Fundus photo; 2352x1568 — 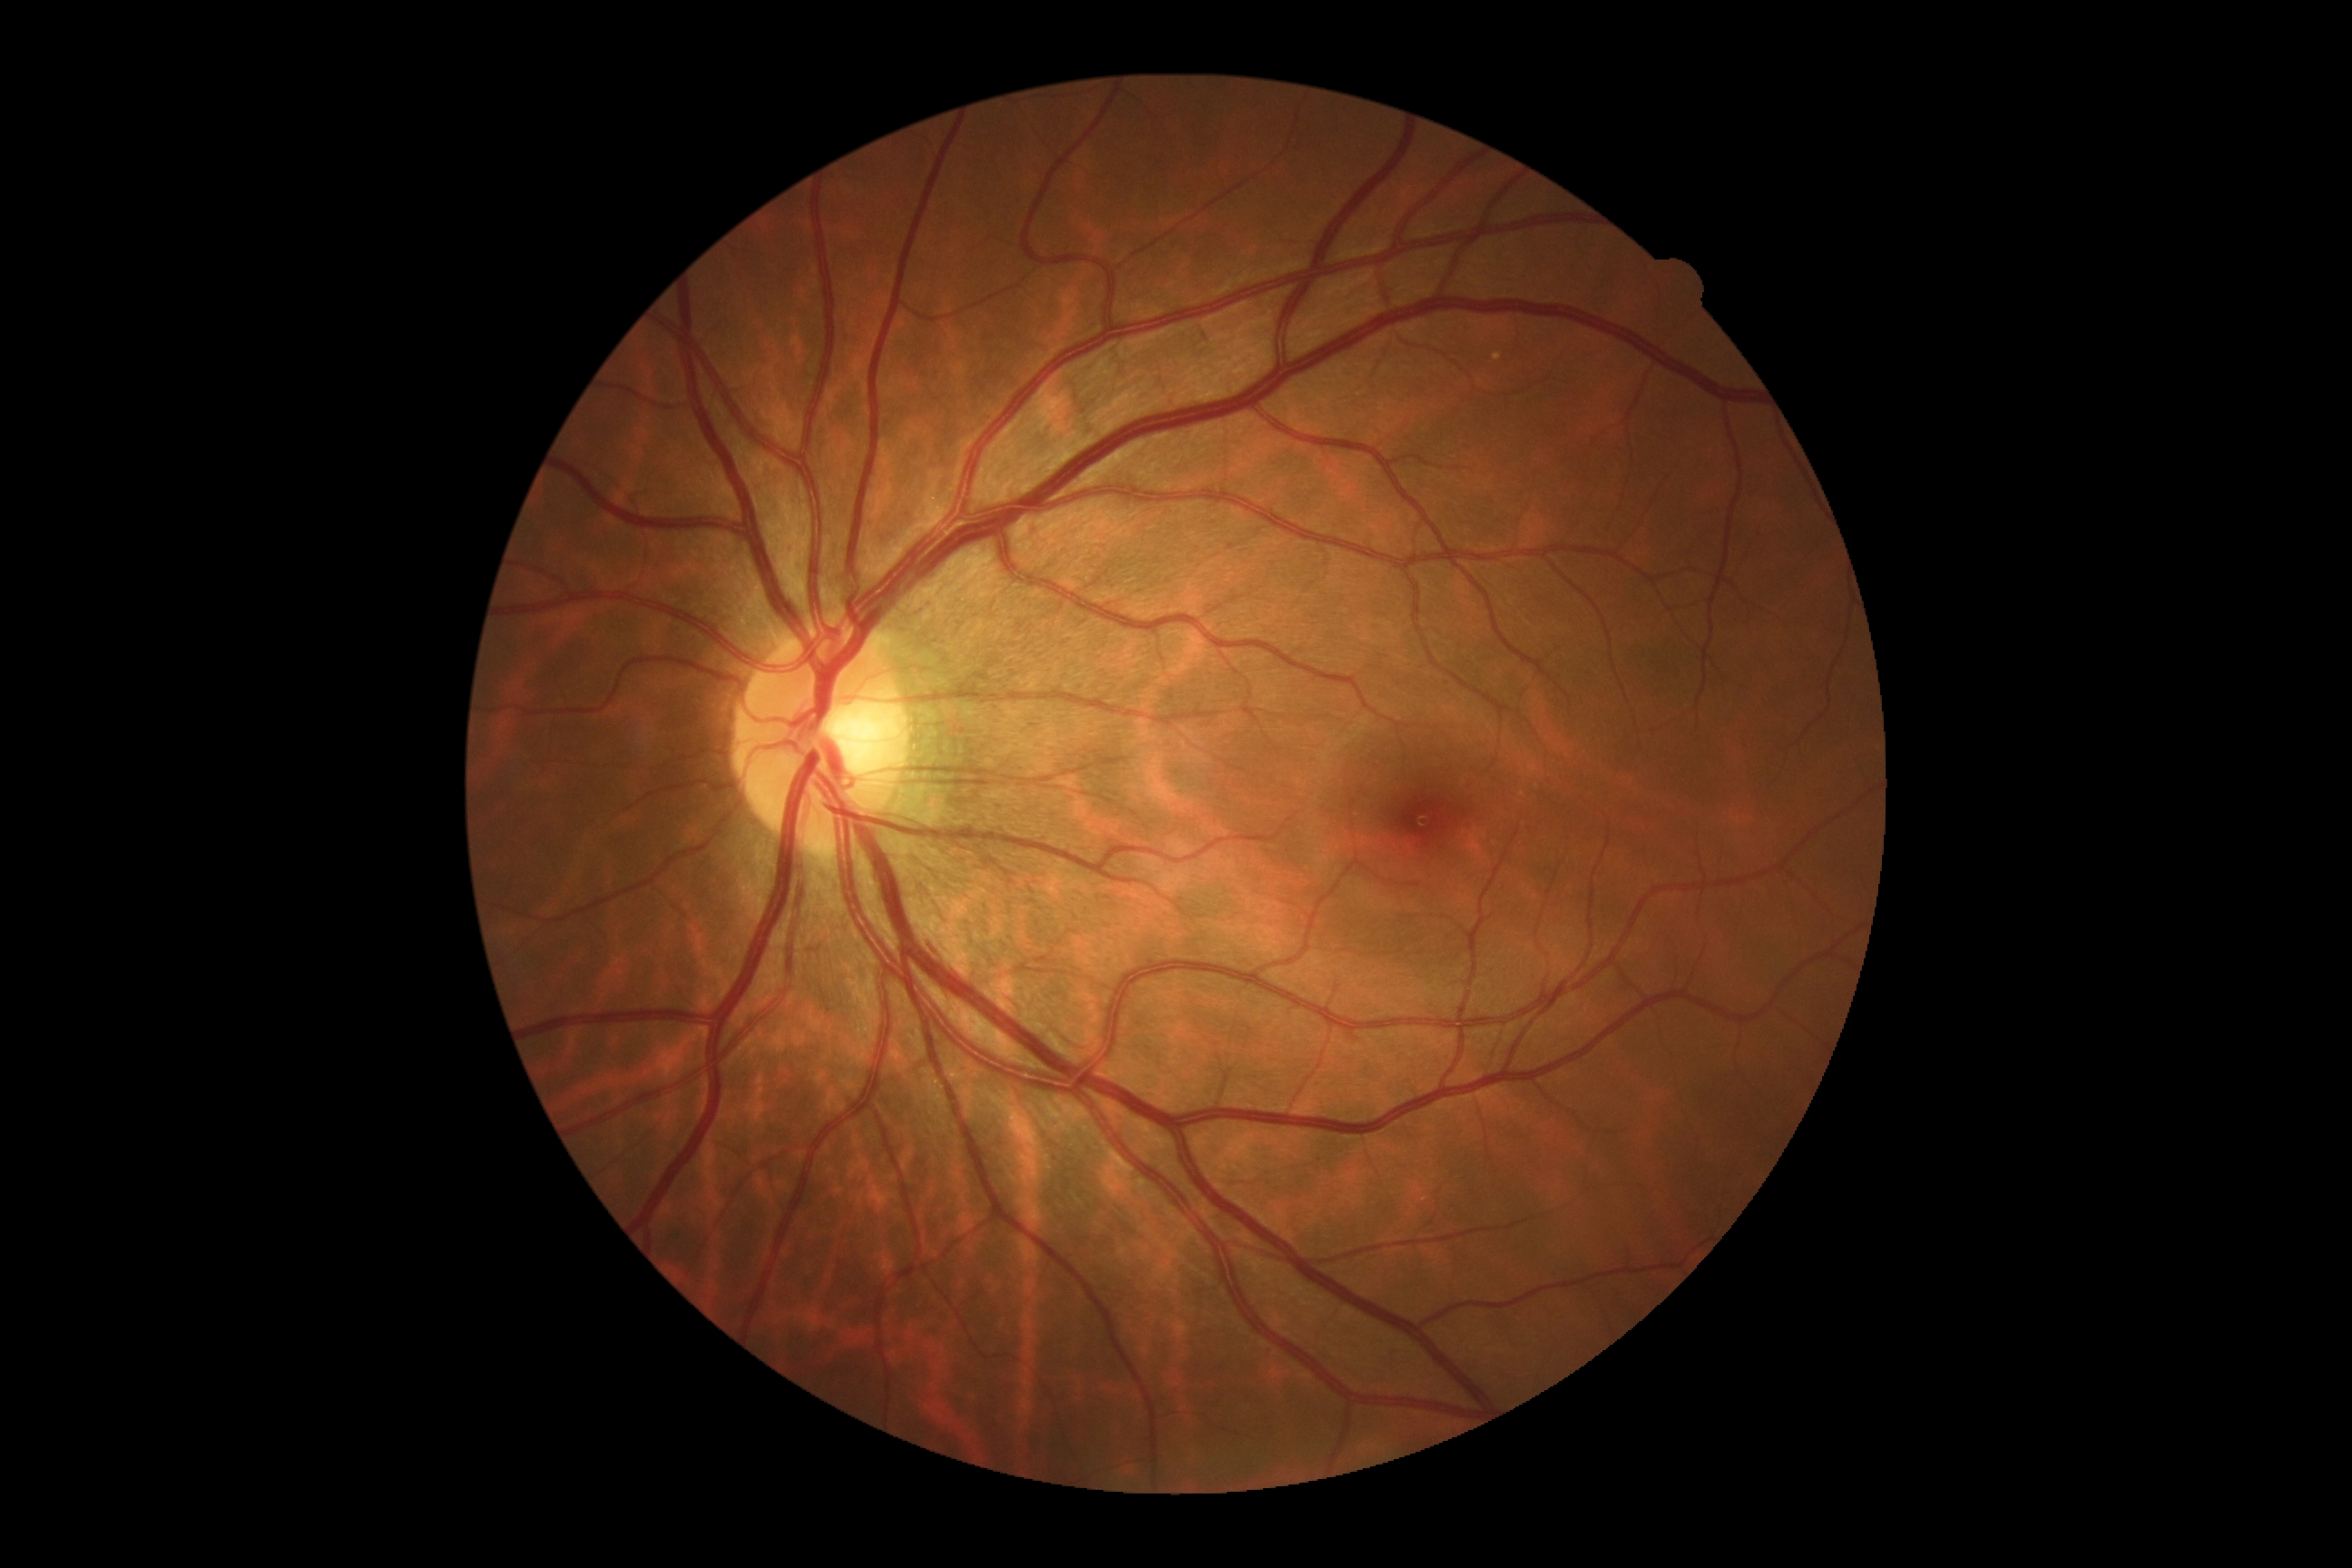
No DR findings.
Diabetic retinopathy grade: 0.